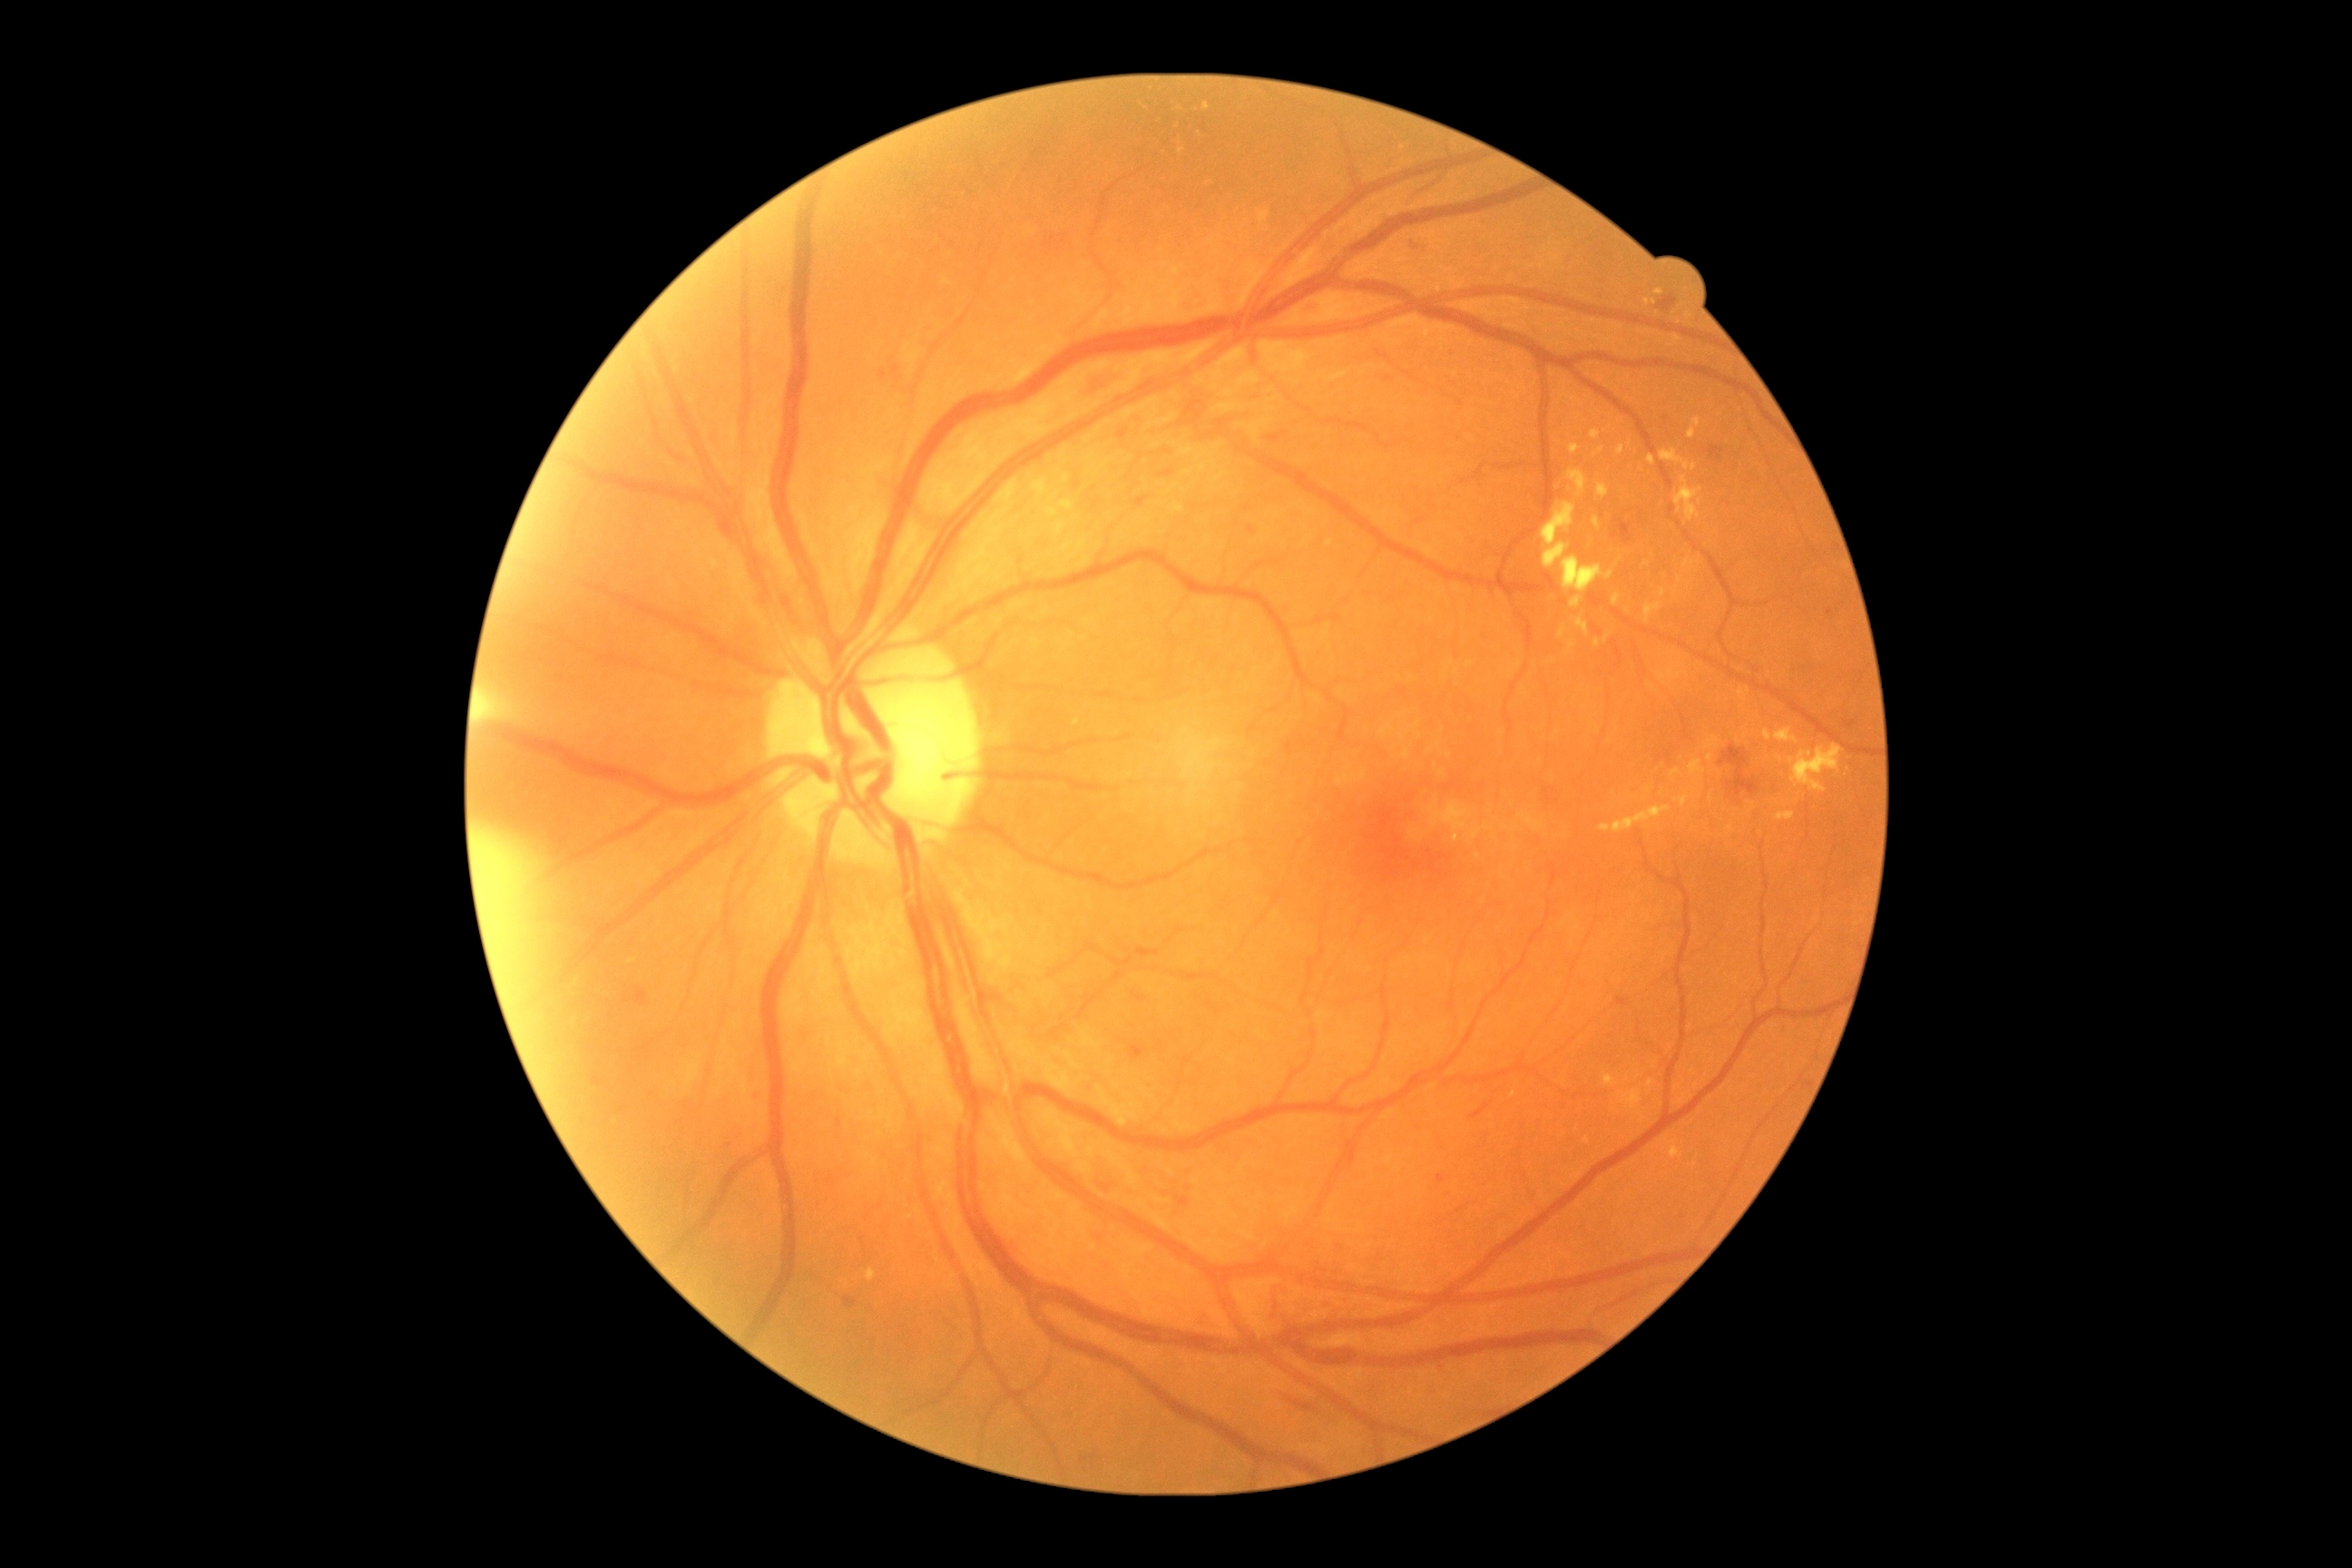
Diabetic retinopathy is grade 2 (moderate NPDR); non-proliferative diabetic retinopathy
Selected lesions:
* hard exudates (subset): 1776/812/1794/821 | 1567/471/1589/498 | 1063/544/1073/551 | 1142/101/1148/110 | 1603/632/1612/643 | 1763/729/1772/741 | 1683/558/1696/569 | 1660/589/1667/598 | 1453/834/1460/843 | 1792/745/1843/794 | 1603/1073/1618/1088 | 1643/603/1661/623
* Smaller hard exudates around x=1586, y=1140 | x=1699, y=502 | x=1752, y=805 | x=1791, y=762